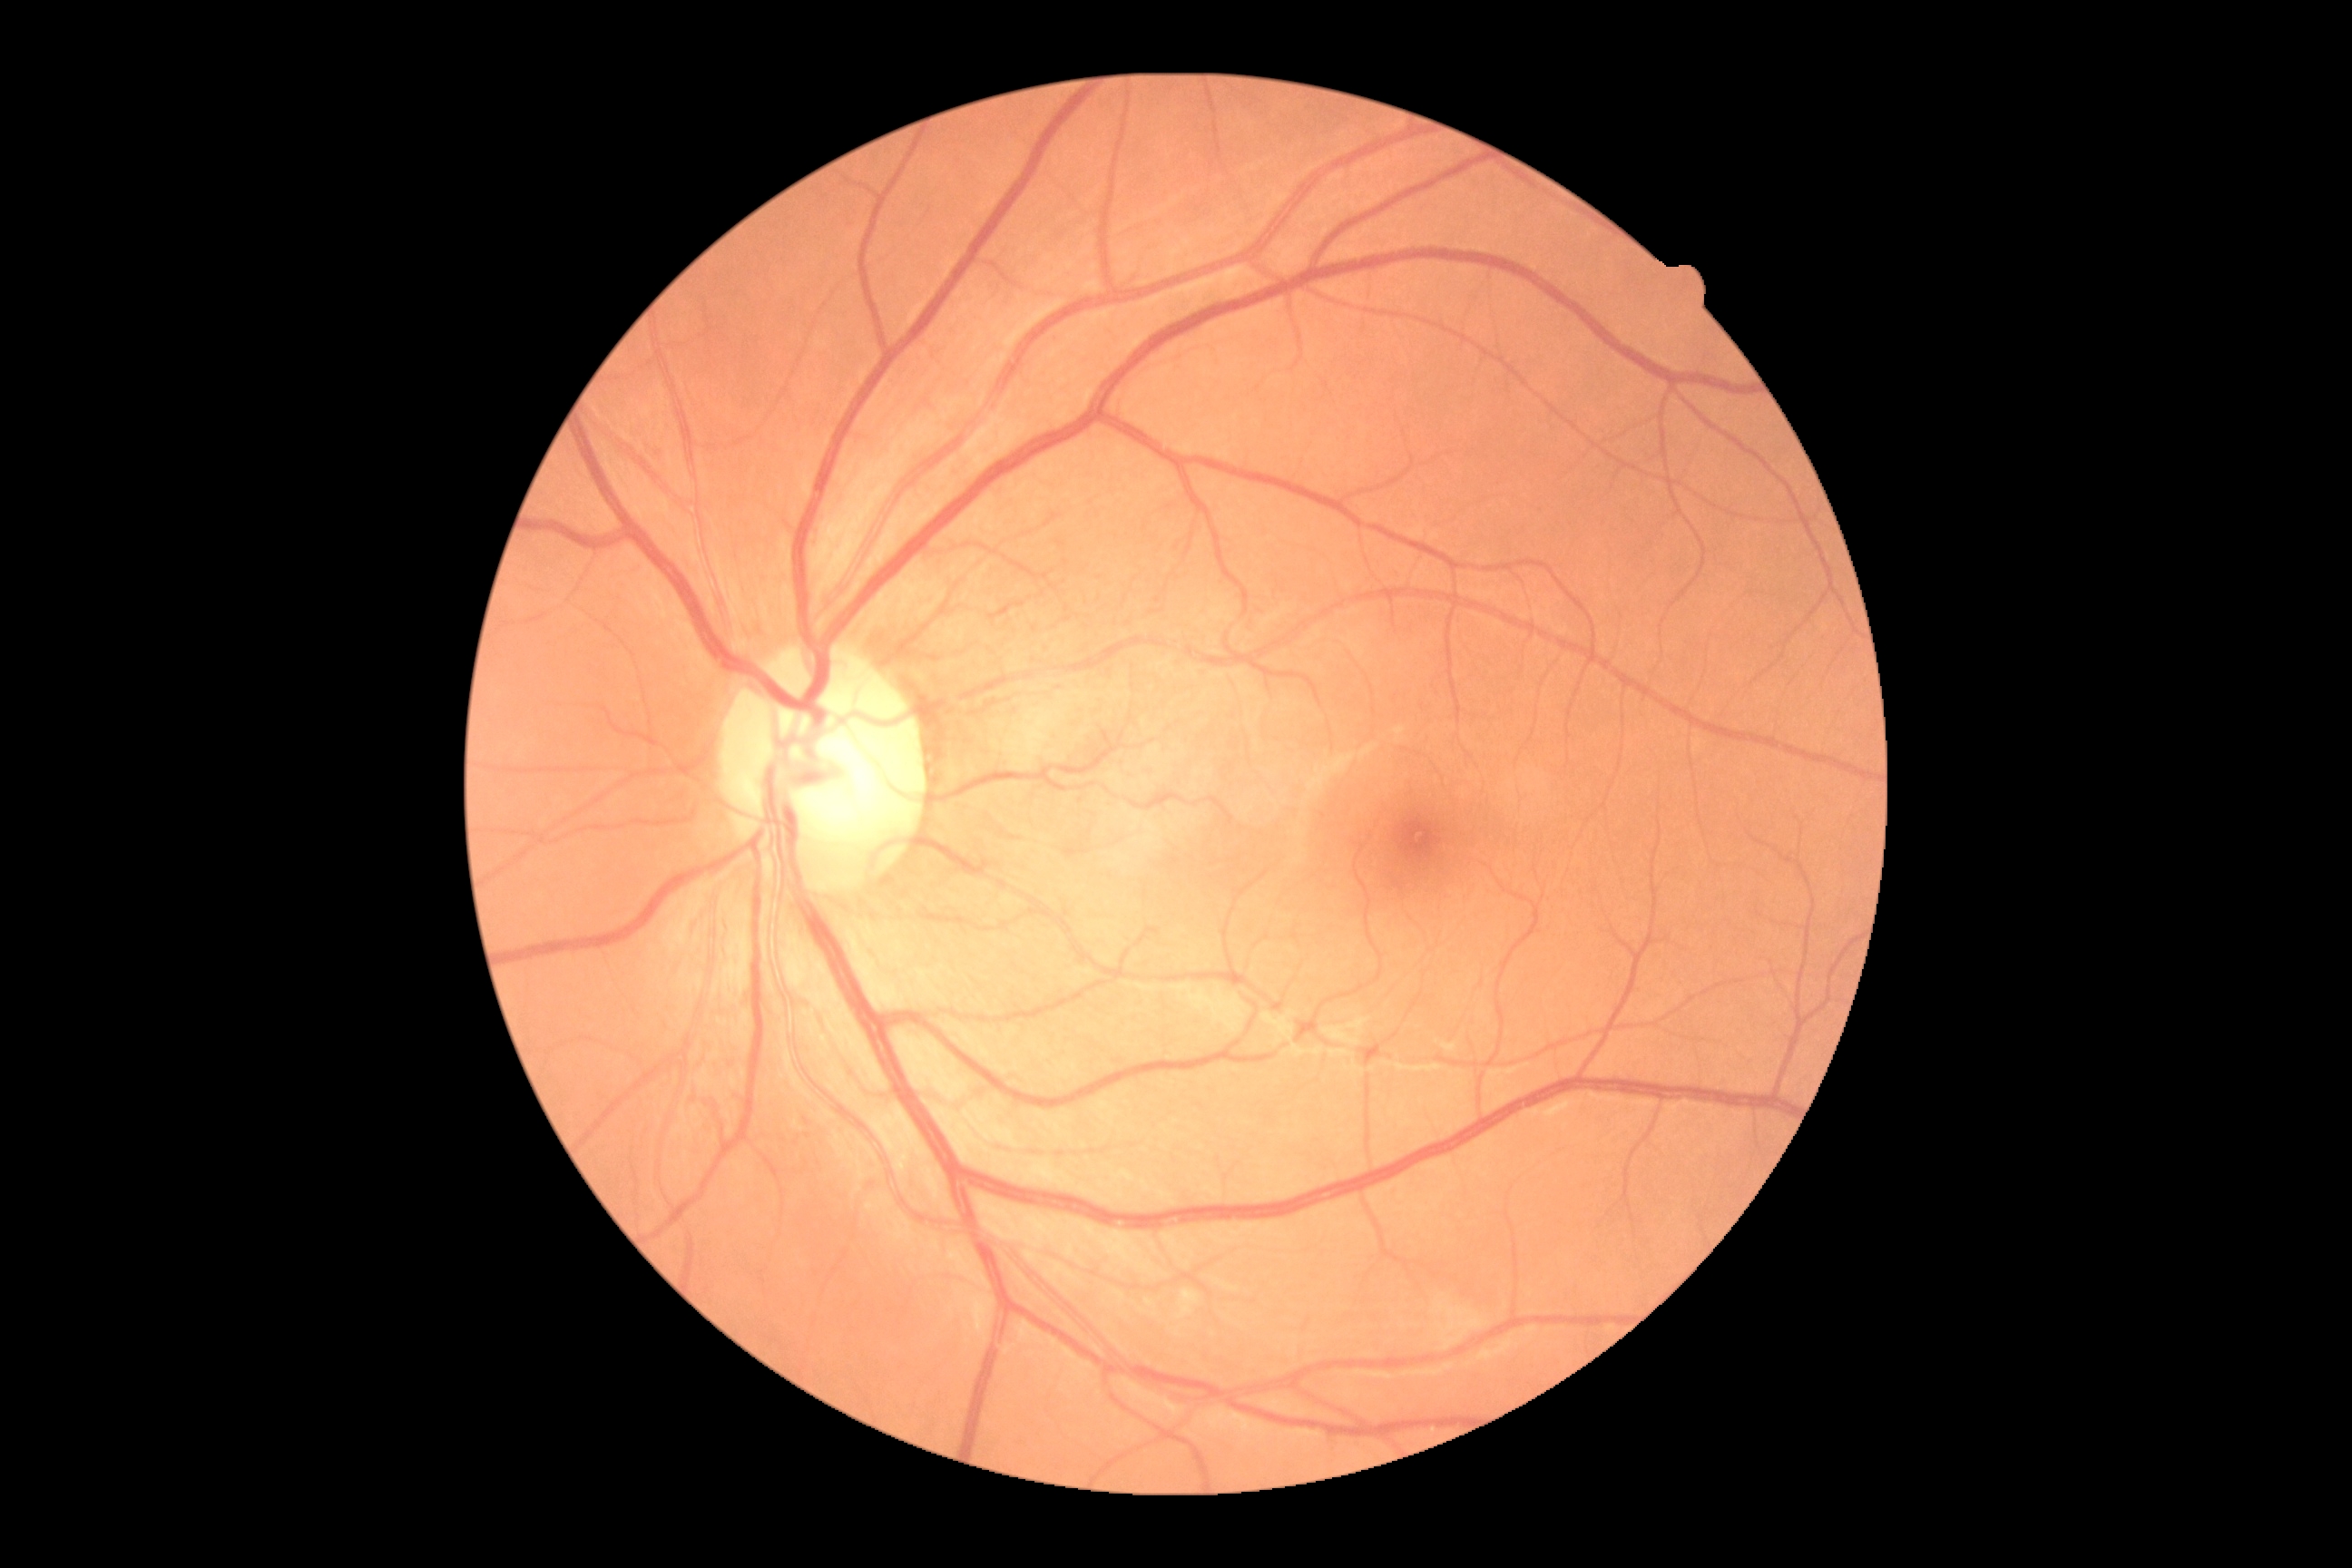
Diabetic retinopathy (DR) is no apparent retinopathy (grade 0).